45° FOV:
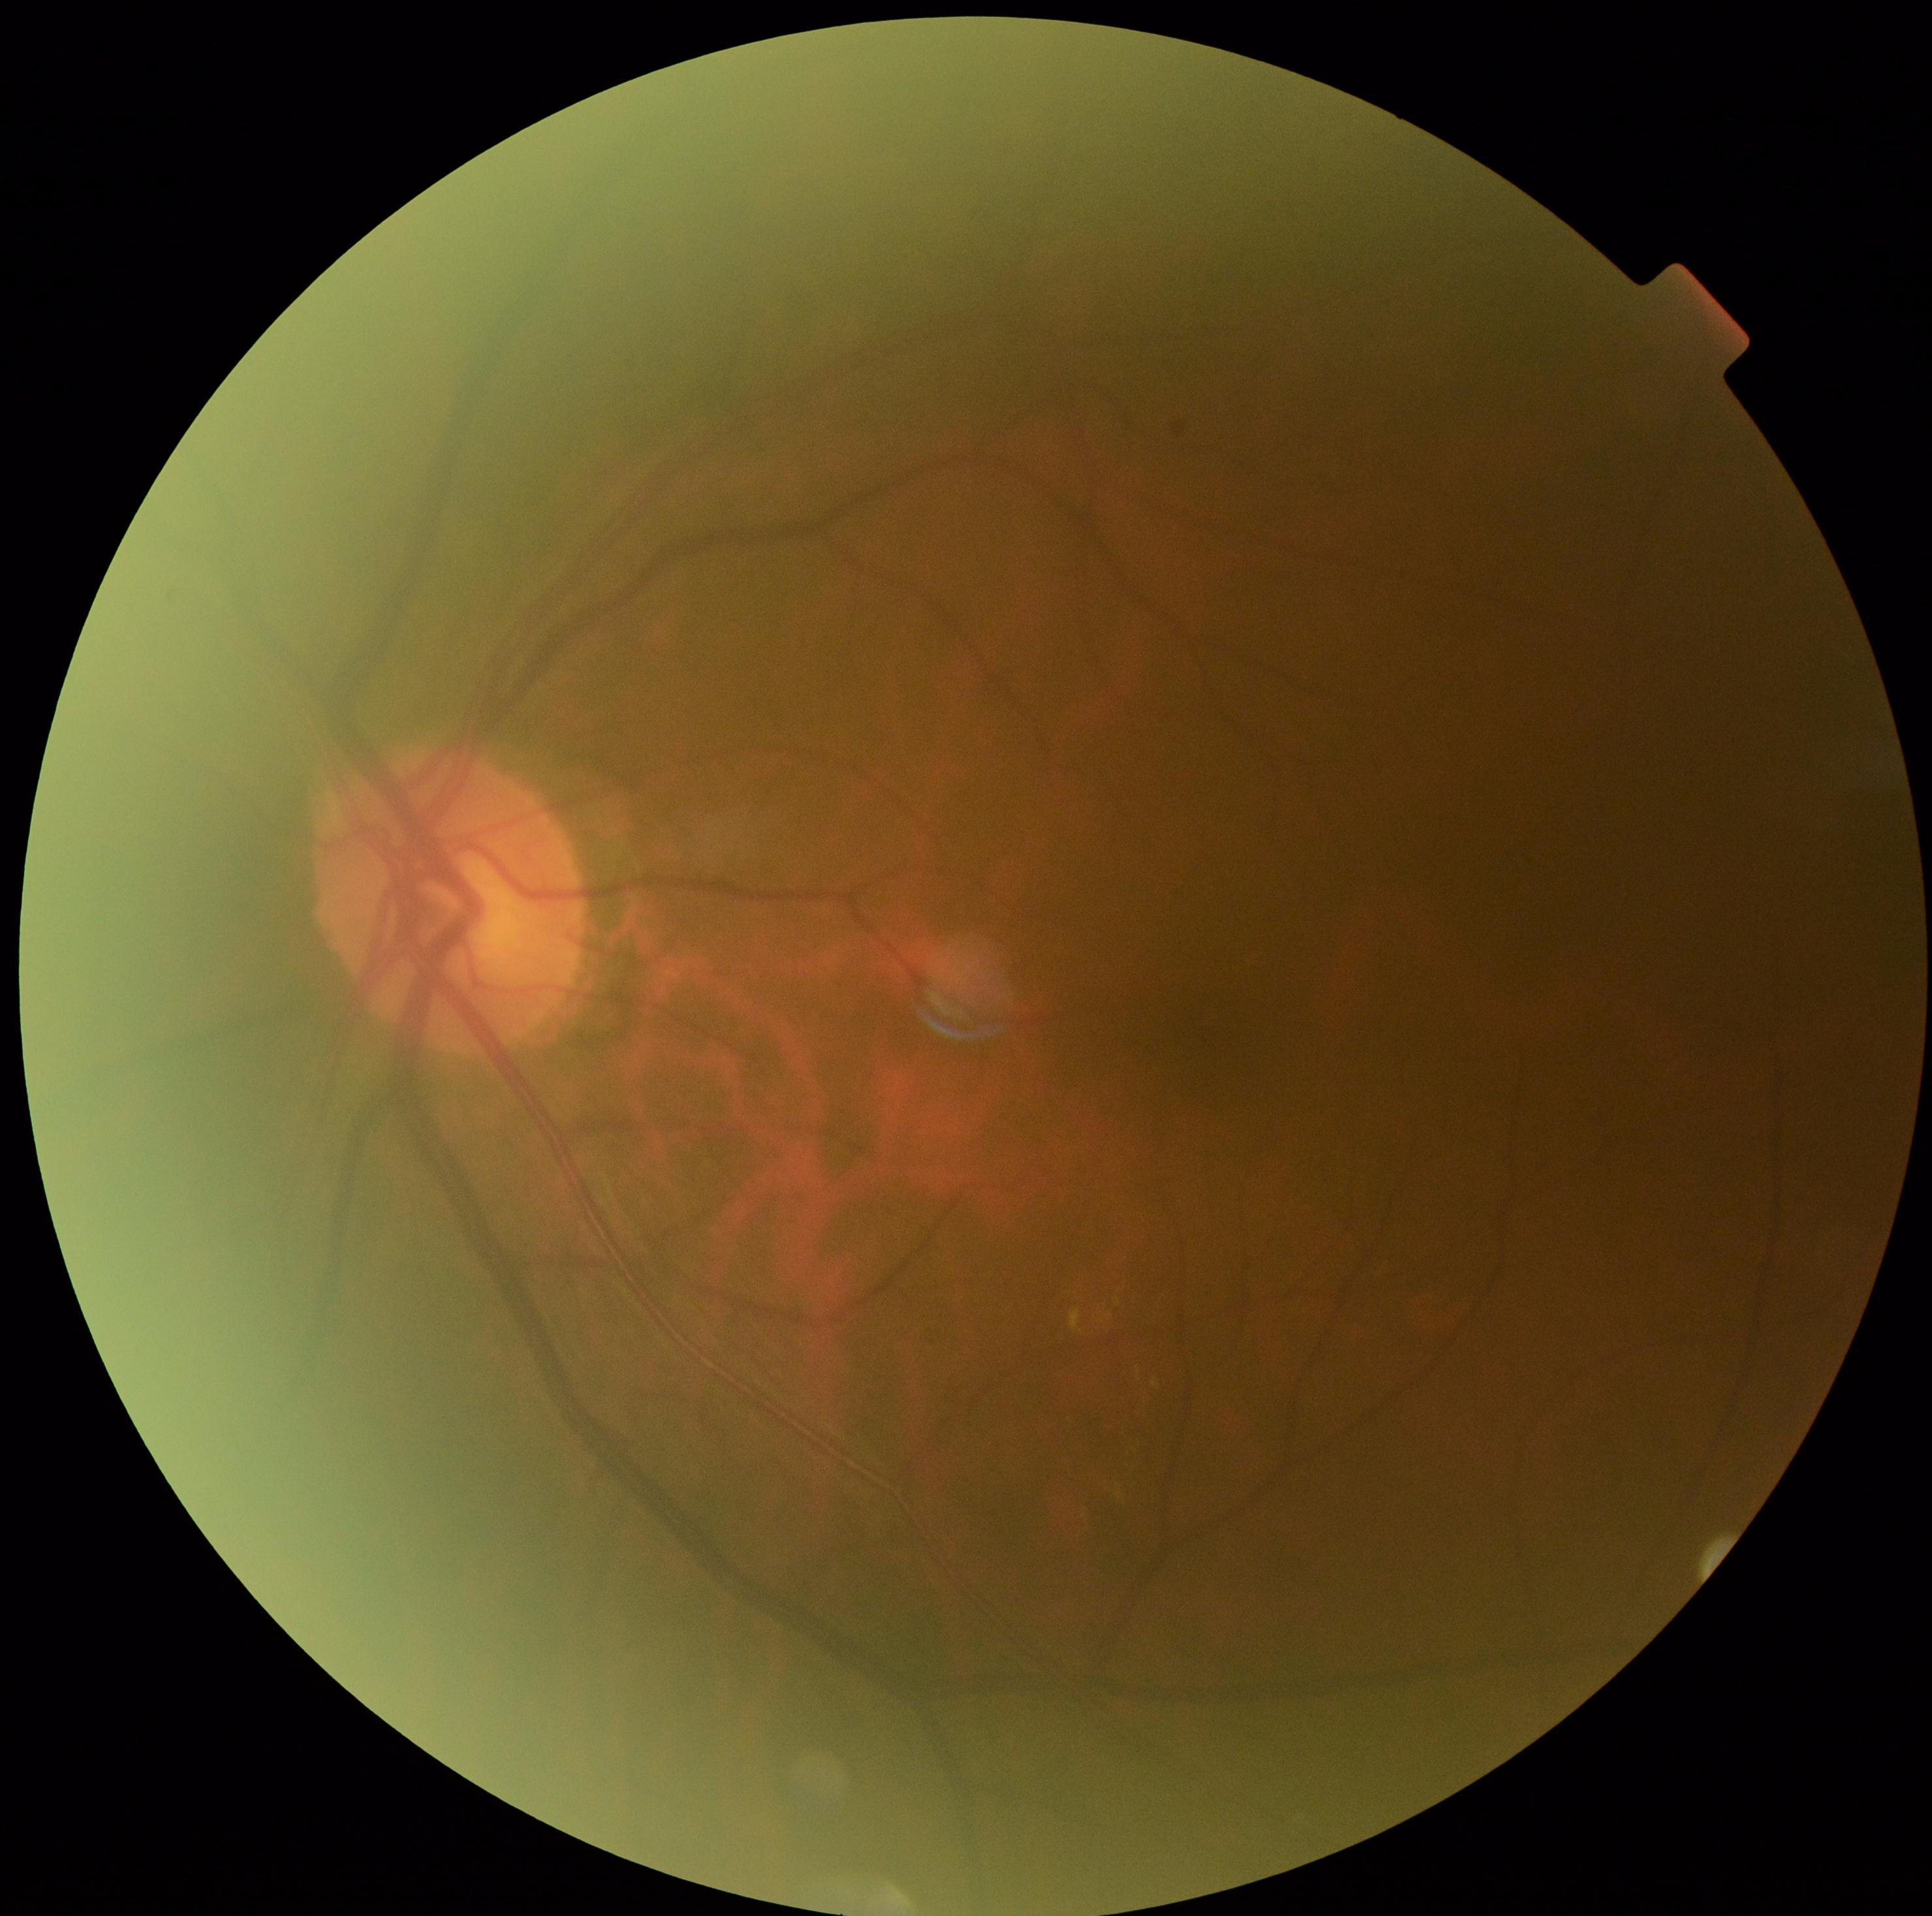

DR class = non-proliferative diabetic retinopathy
retinopathy grade = moderate non-proliferative diabetic retinopathy (2)